Image size 848x848; 45° field of view; color fundus image; nonmydriatic fundus photograph:
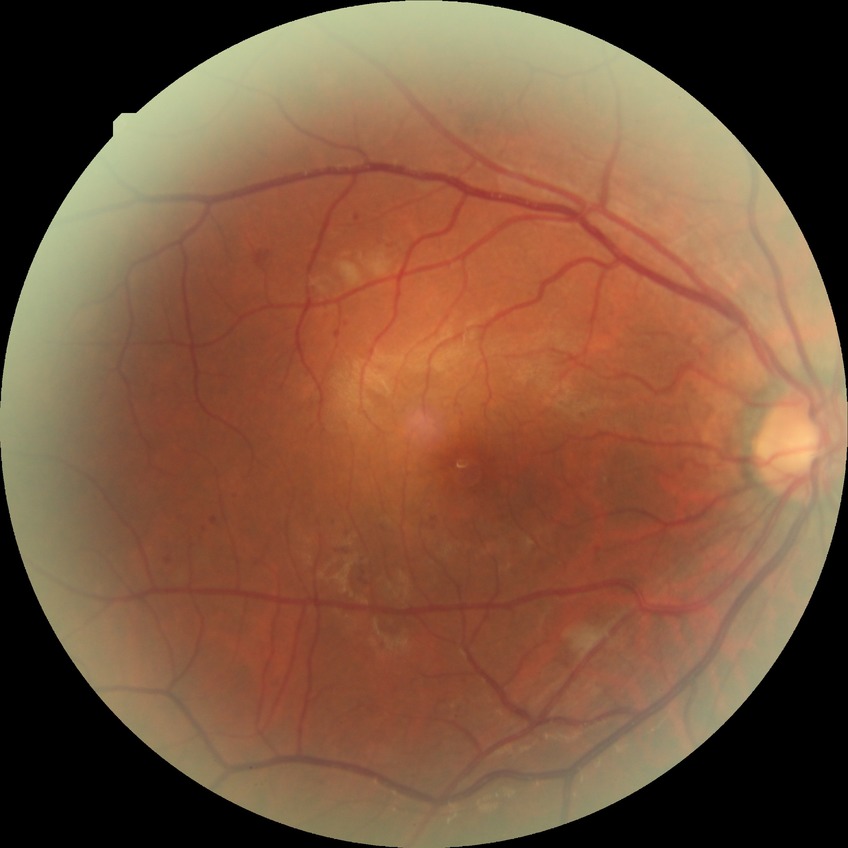 {"proliferative_class": "non-proliferative diabetic retinopathy", "davis_grade": "pre-proliferative diabetic retinopathy"}